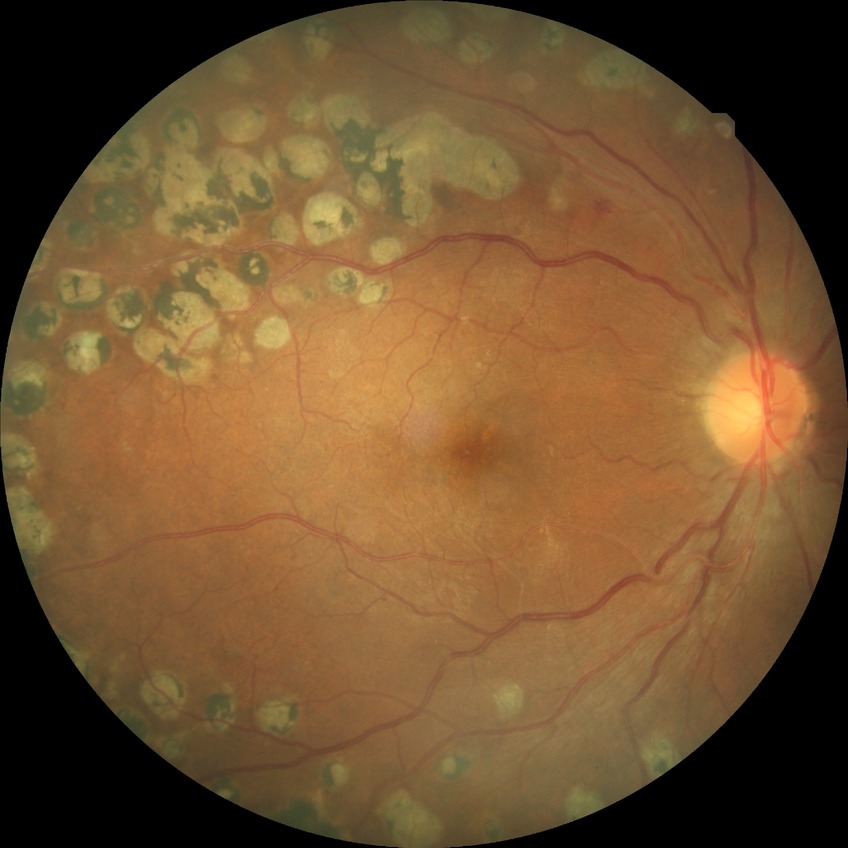 DR is PDR.